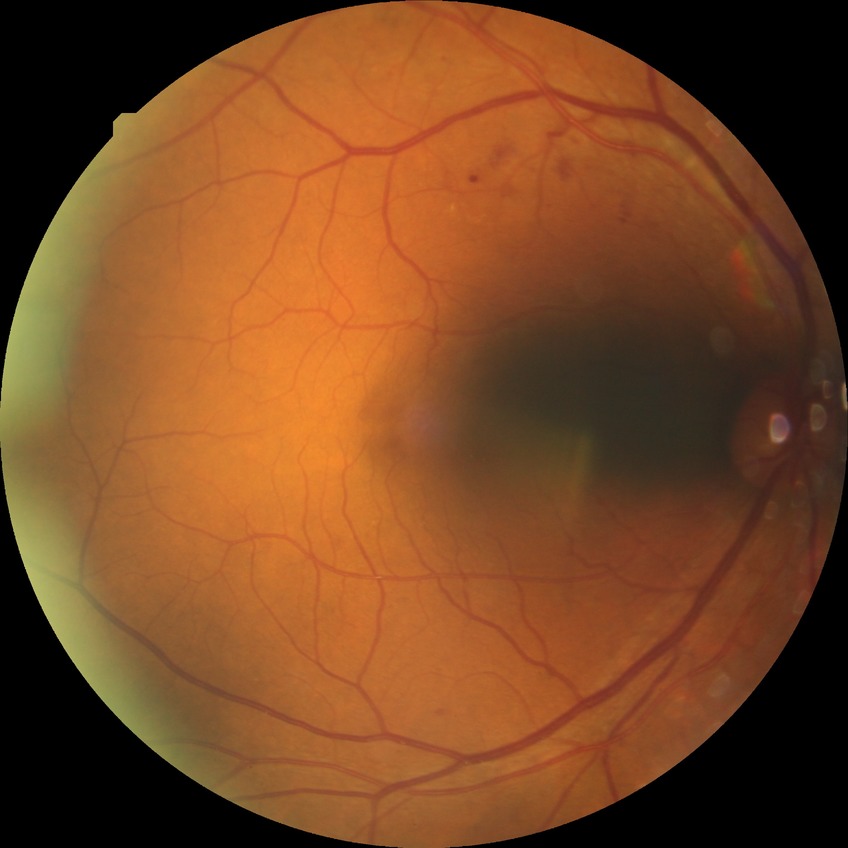
DR severity is SDR.